45° FOV — 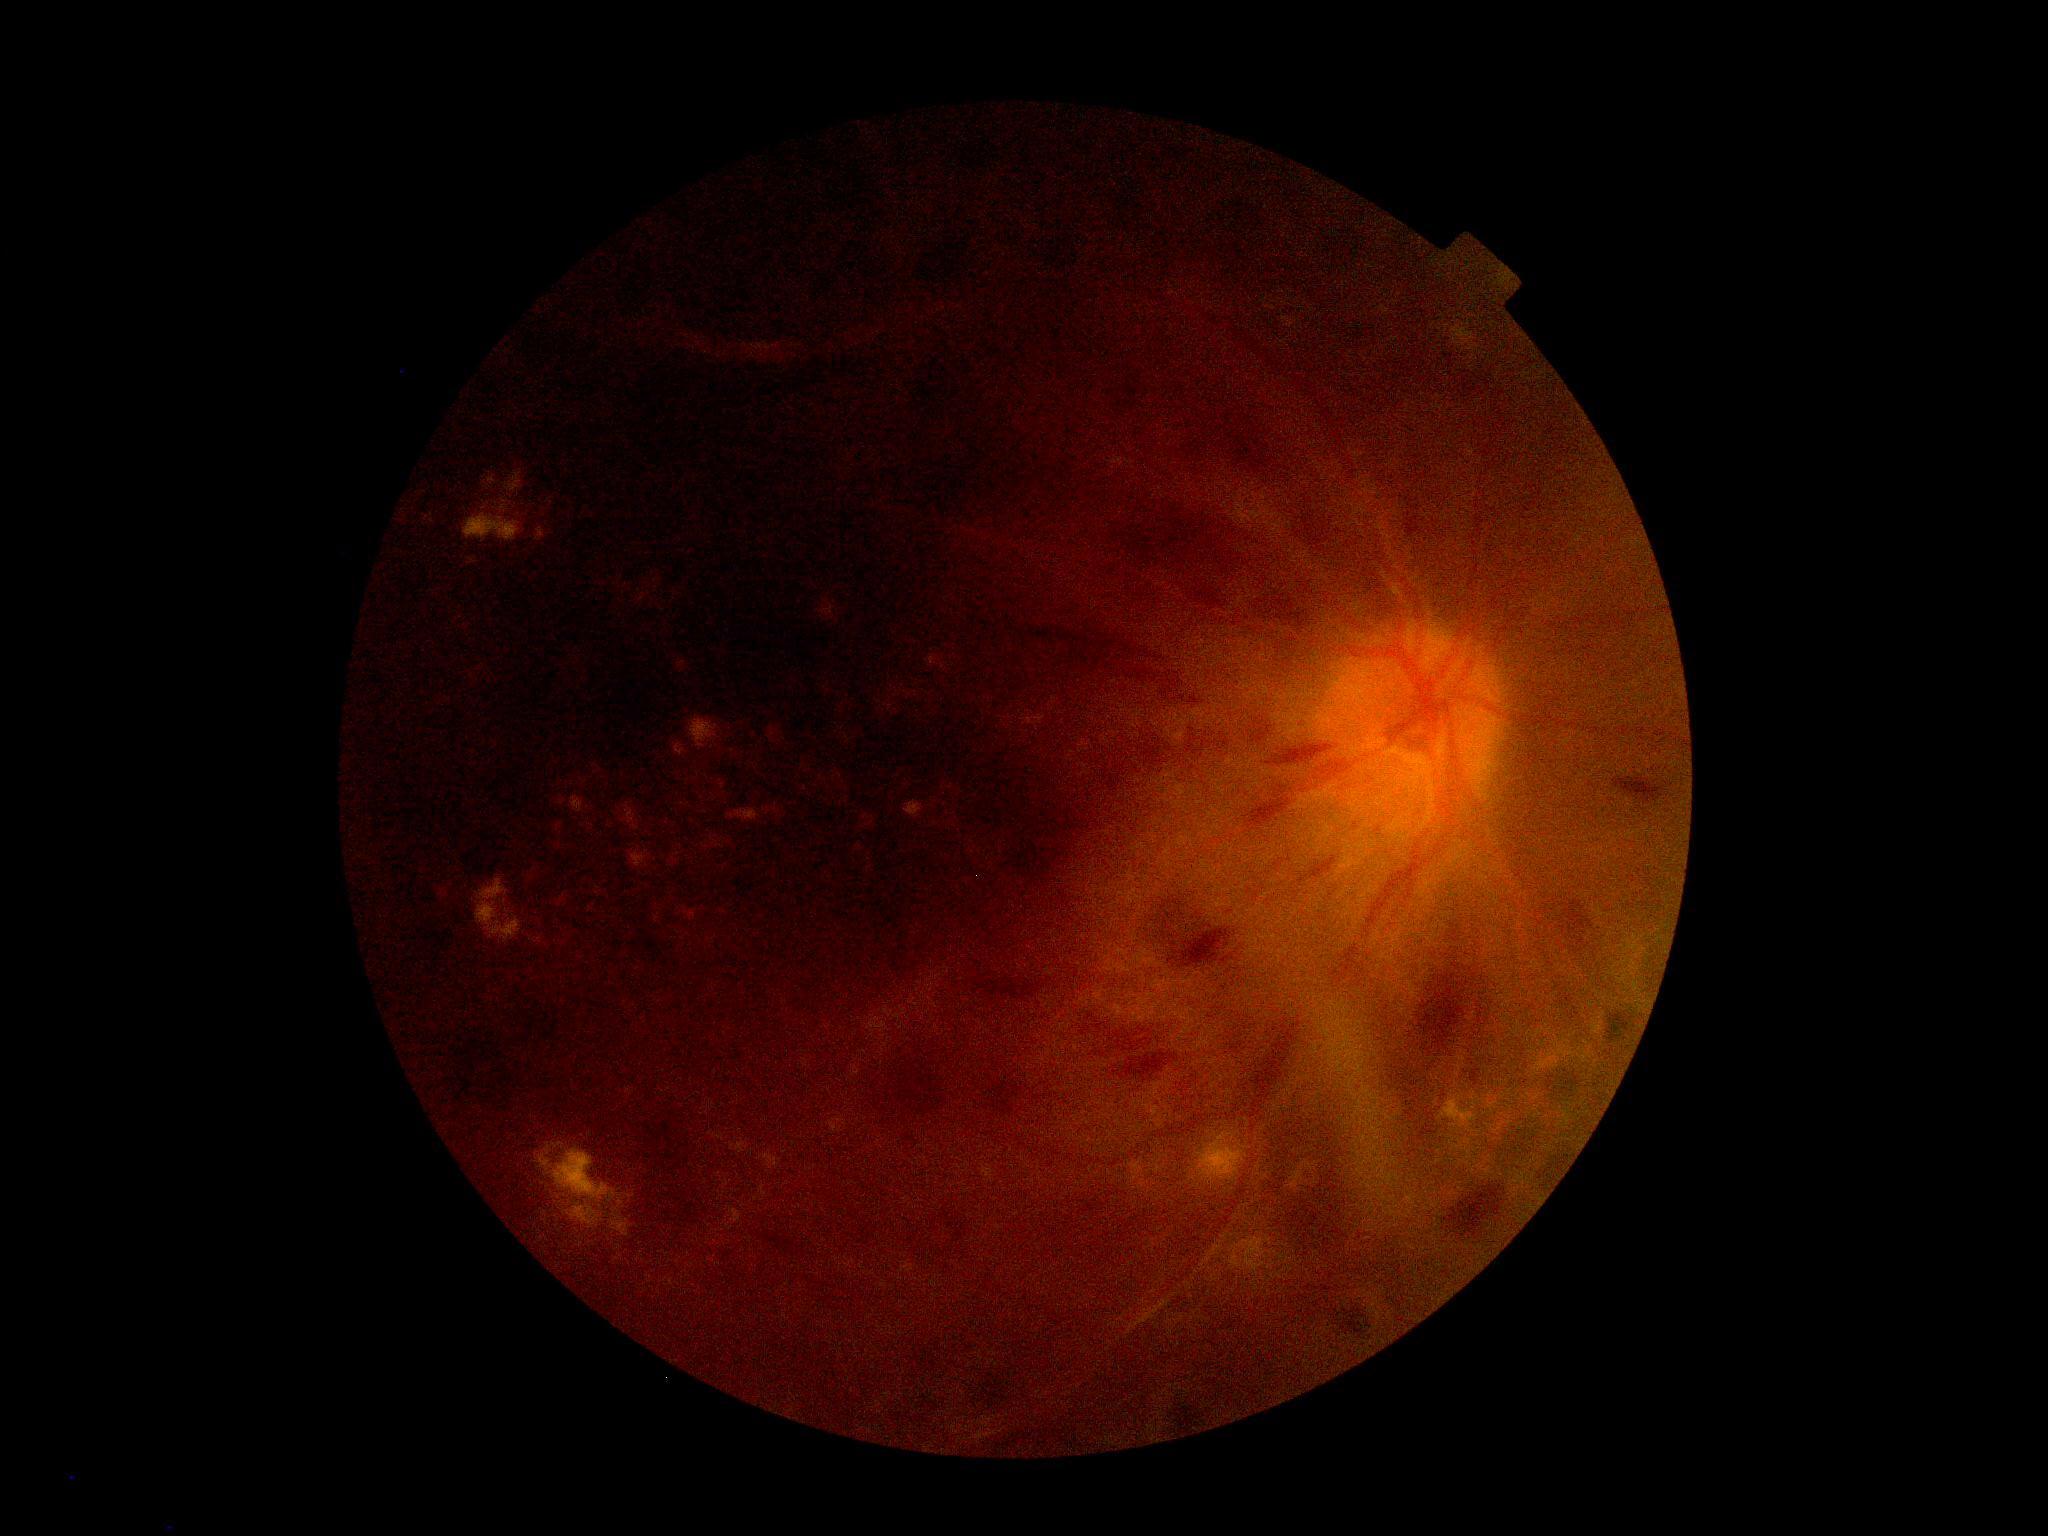
DR severity is severe NPDR (grade 3) — more than 20 intraretinal hemorrhages in each of 4 quadrants, definite venous beading in 2 or more quadrants, or prominent intraretinal microvascular abnormalities in 1 or more quadrants, with no signs of proliferative retinopathy.
Disease class: non-proliferative diabetic retinopathy.